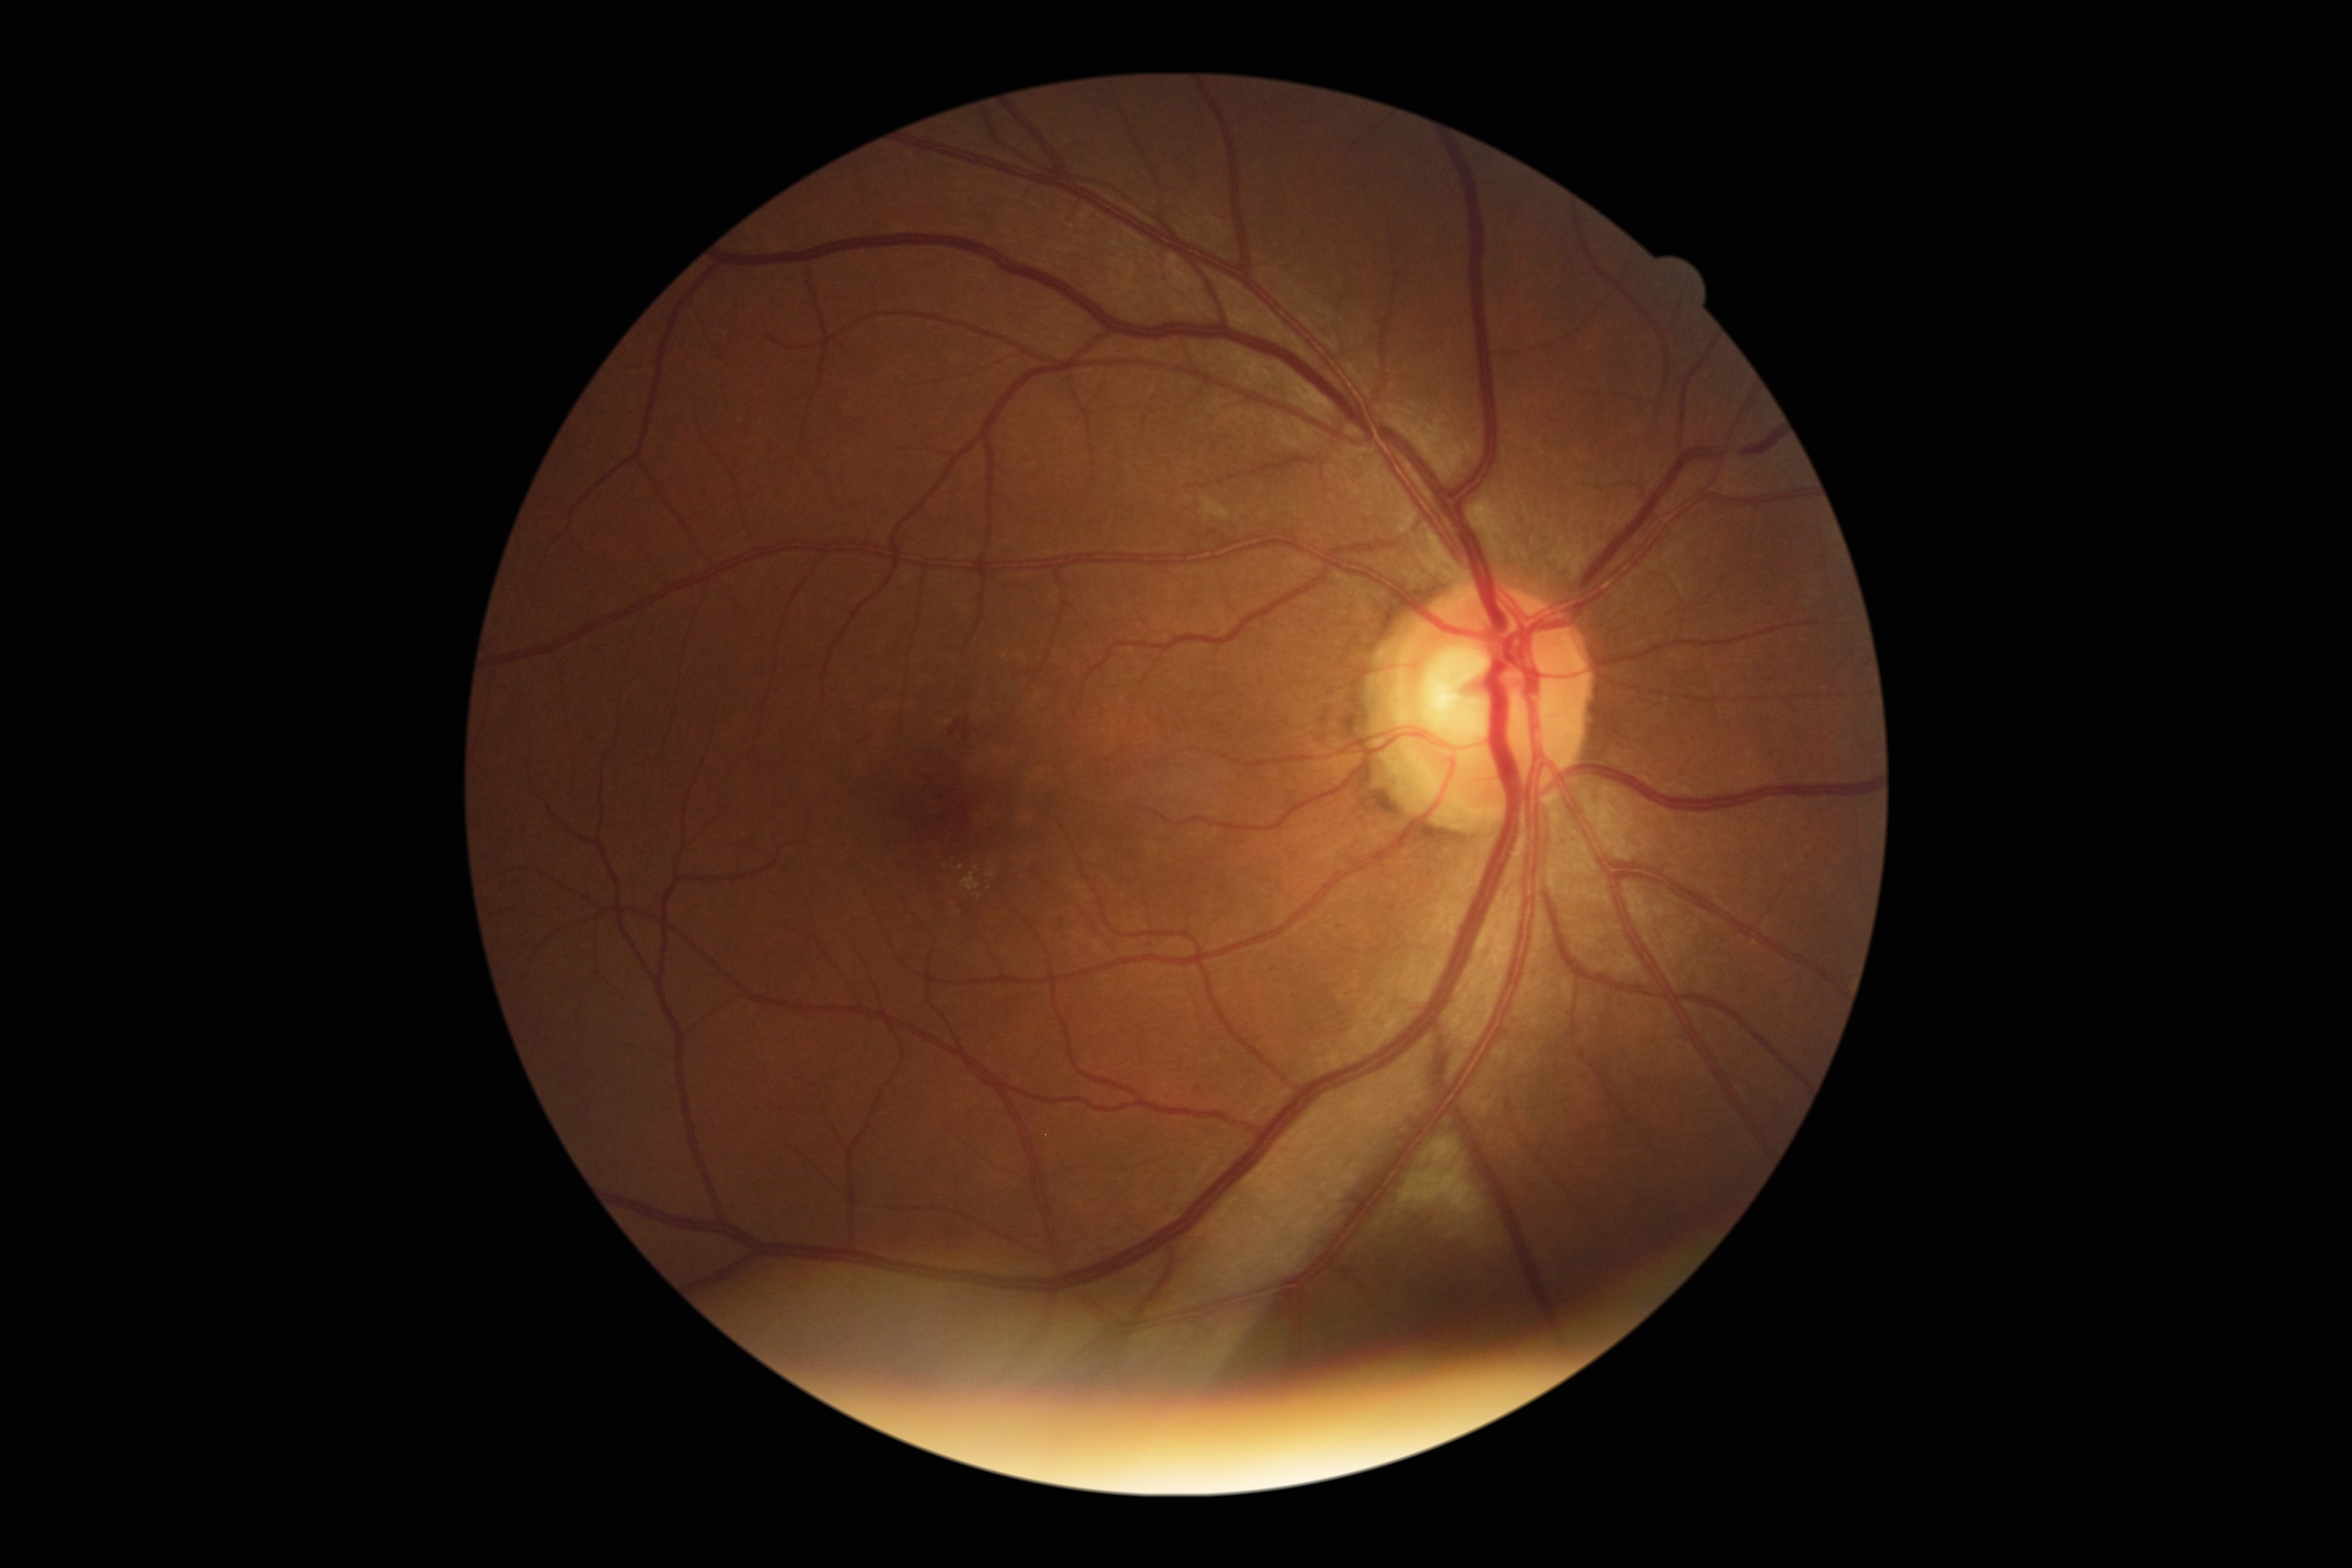
DR severity is grade 2.